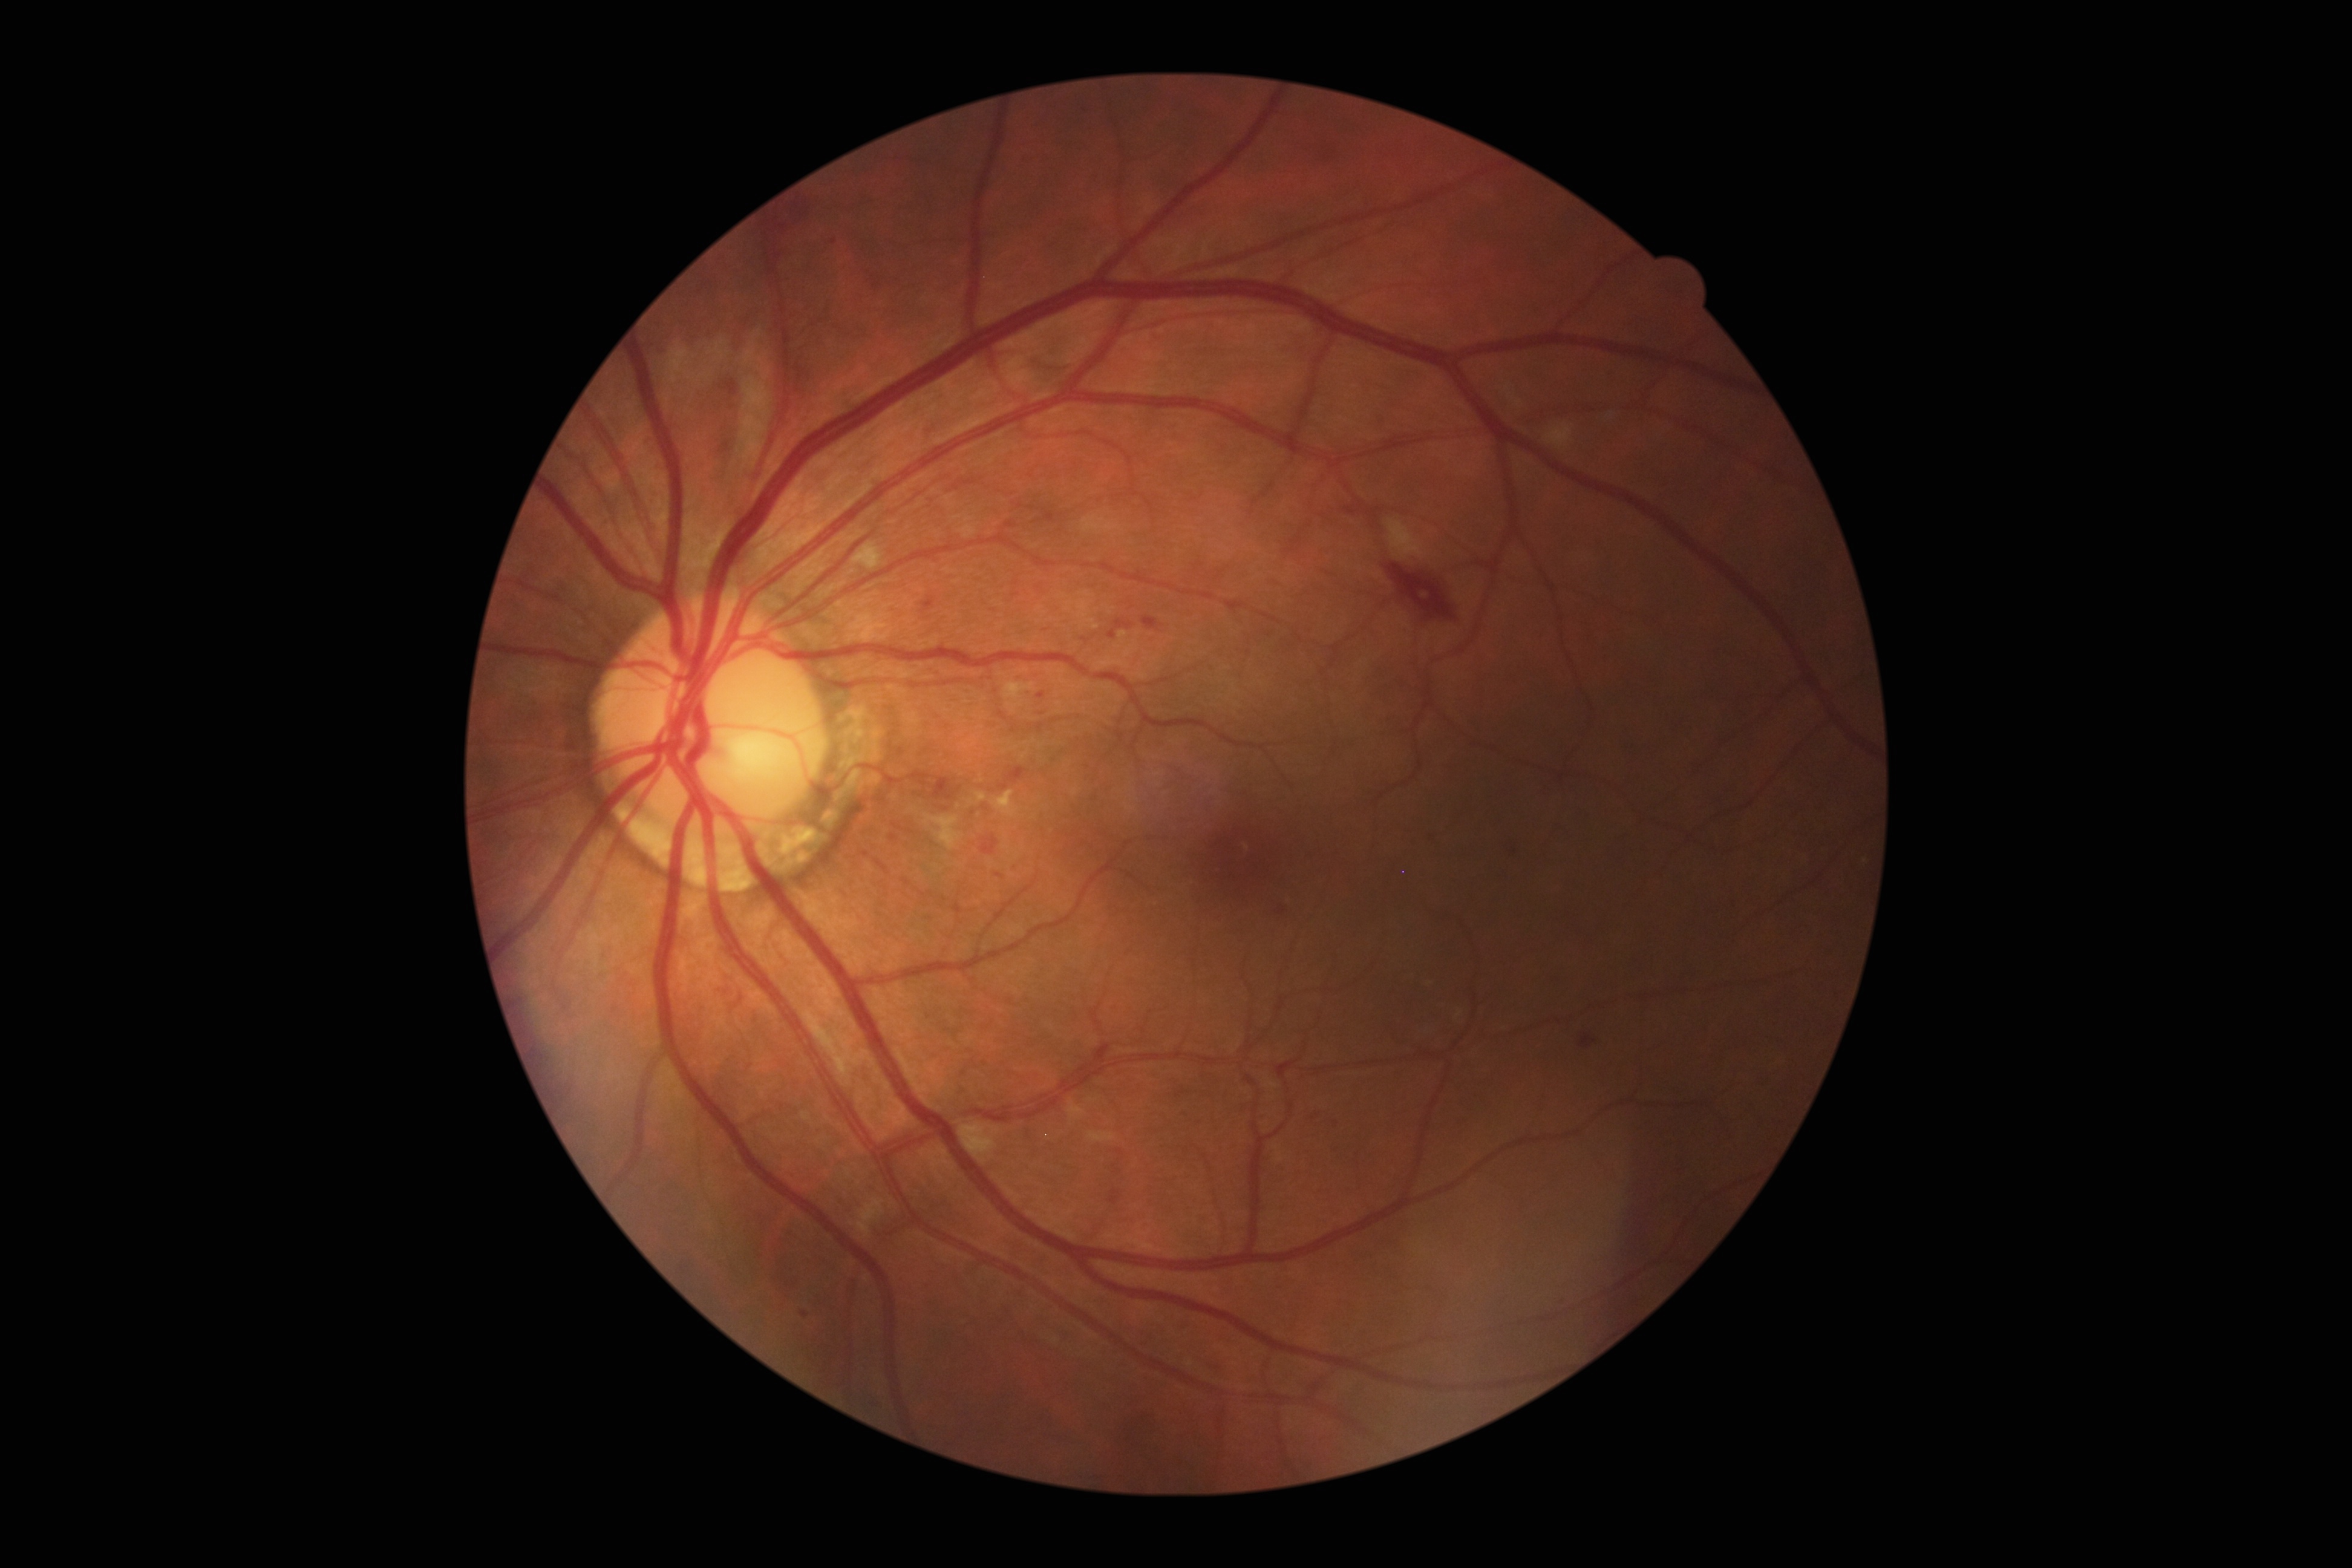
Diabetic retinopathy grade is 2.
Disease class: non-proliferative diabetic retinopathy.